CFP · 1659 x 2212 pixels — 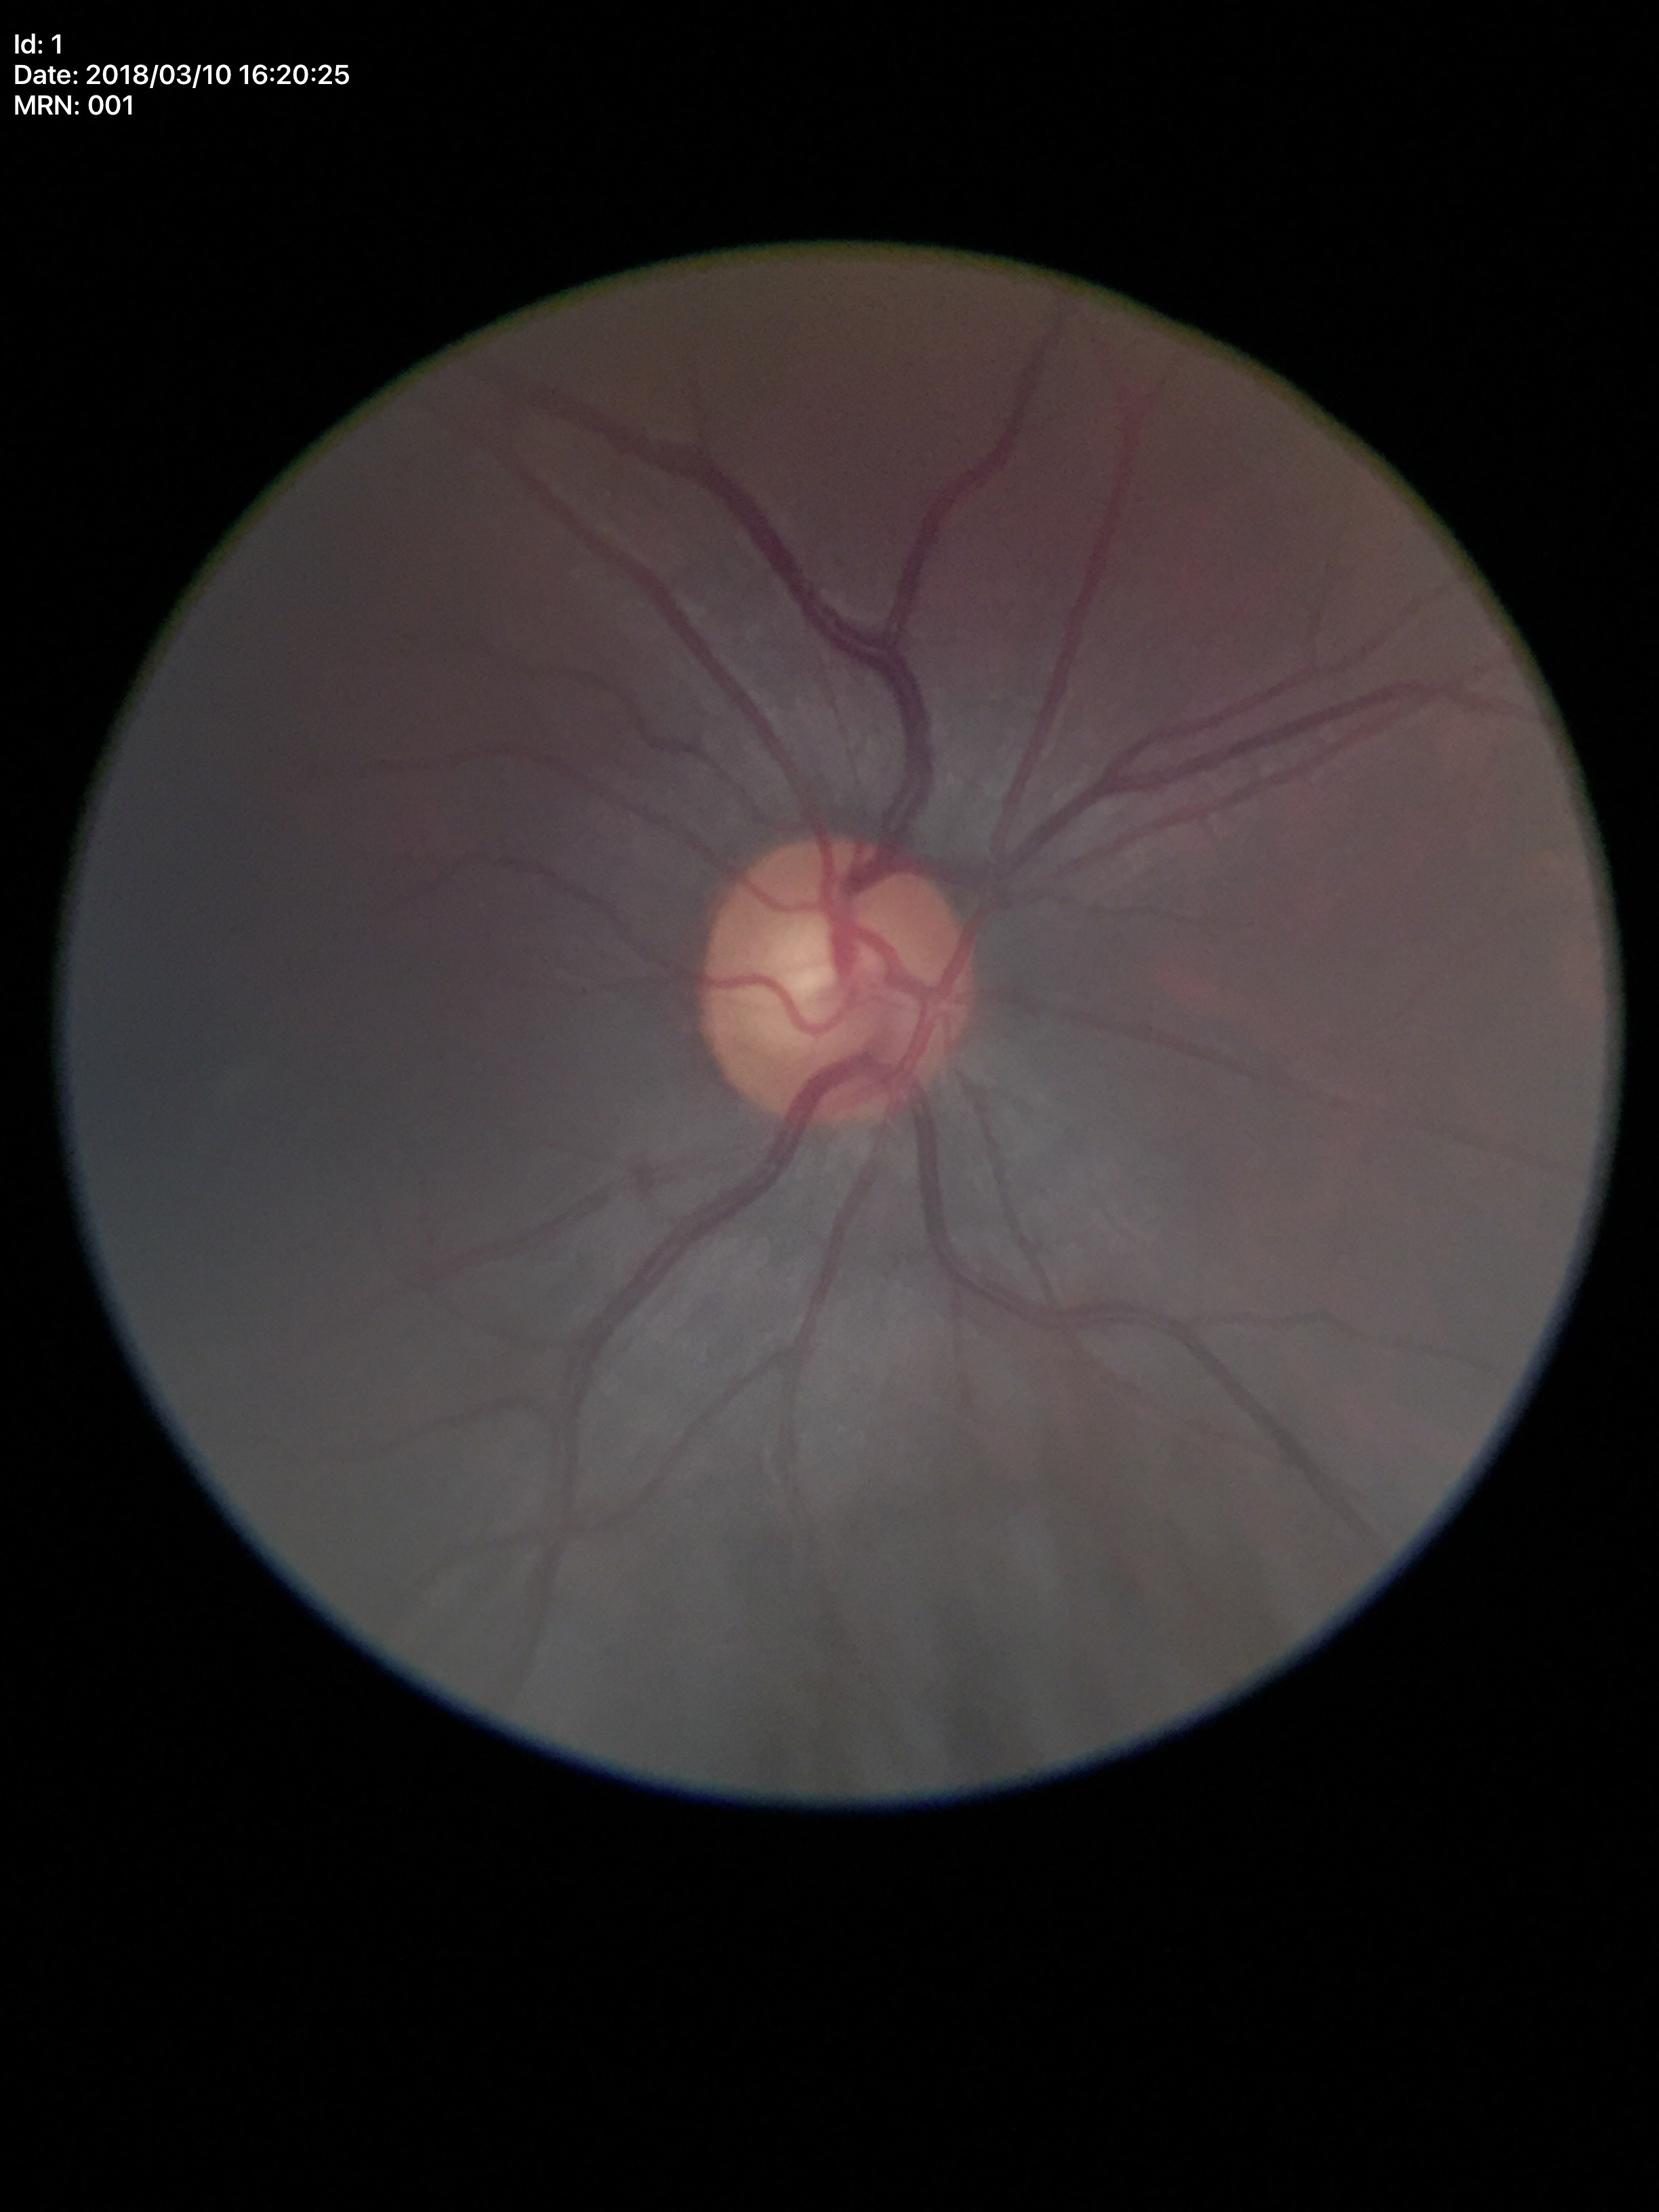 Vertical CDR of 0.56. No evidence of glaucoma (one of five ophthalmologists flagged glaucoma suspect). Horizontal C/D ratio: 0.52.